240x240px:
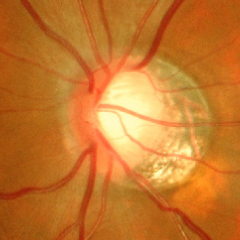

Glaucomatous changes are present. Demonstrates advanced glaucoma.